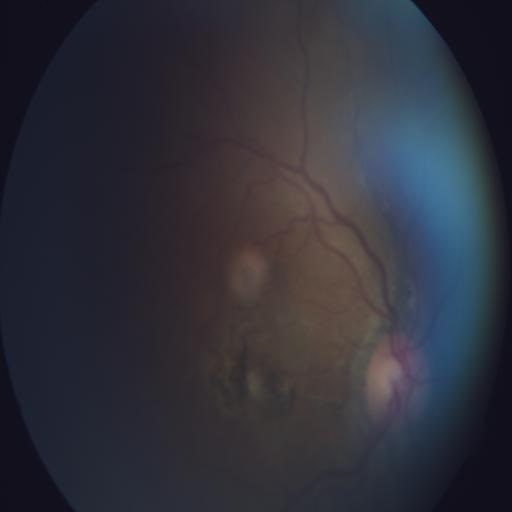
There is evidence of chorioretinitis.